Image size 1240x1240; infant wide-field retinal image; acquired on the Phoenix ICON — 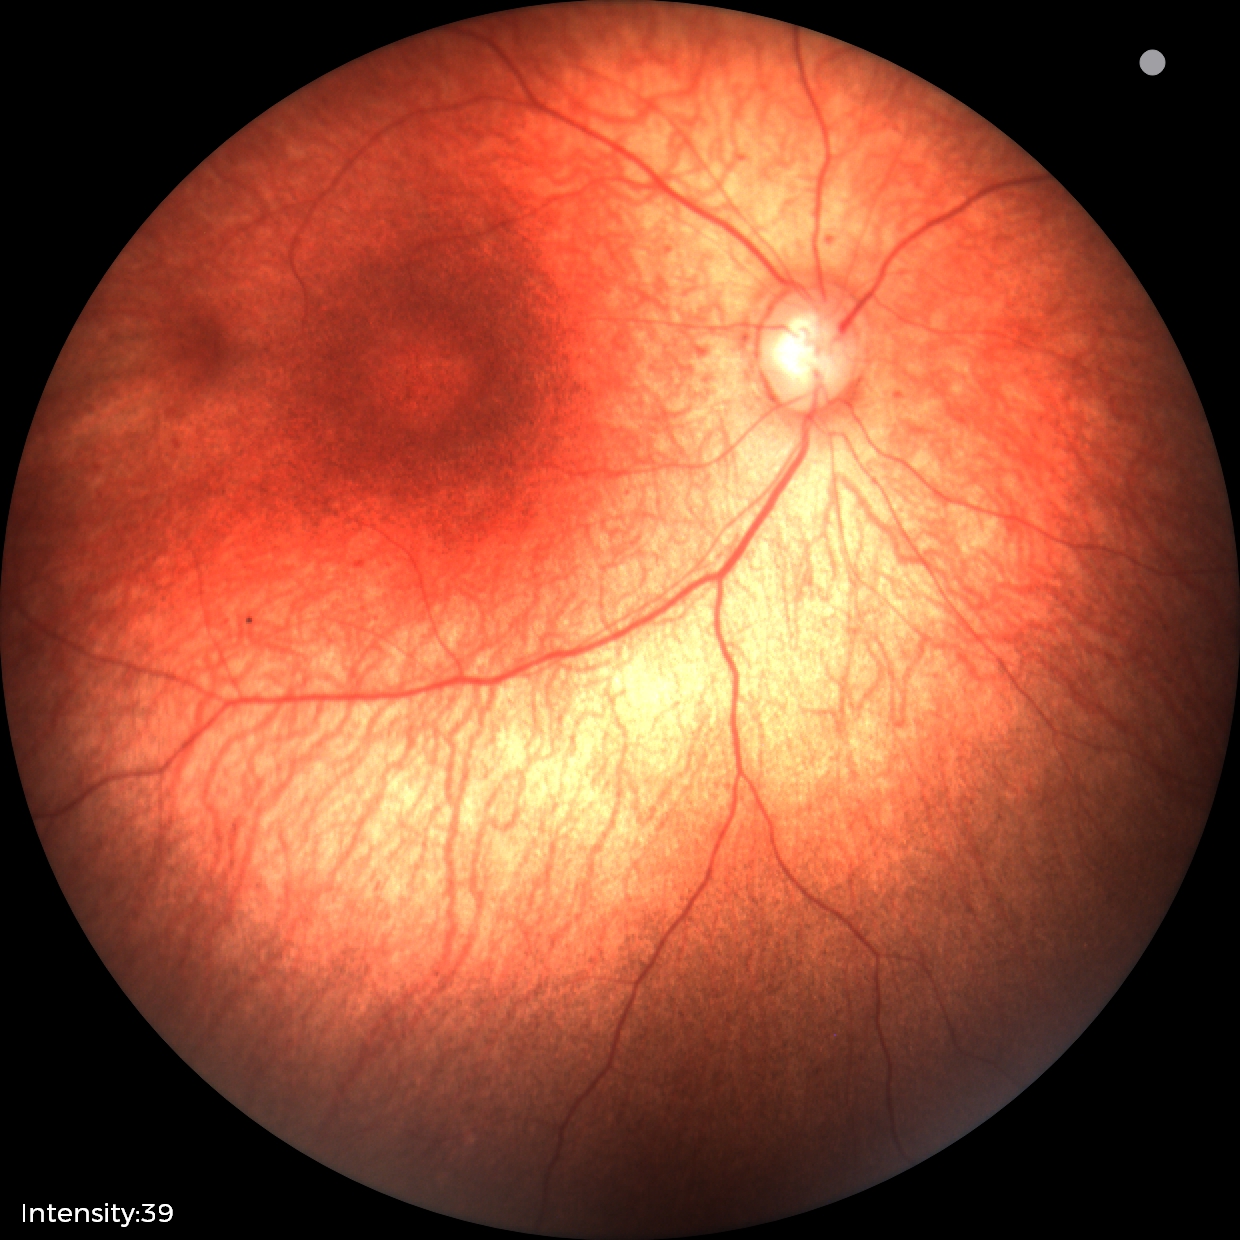
Assessment: physiological appearance with no retinal pathology.